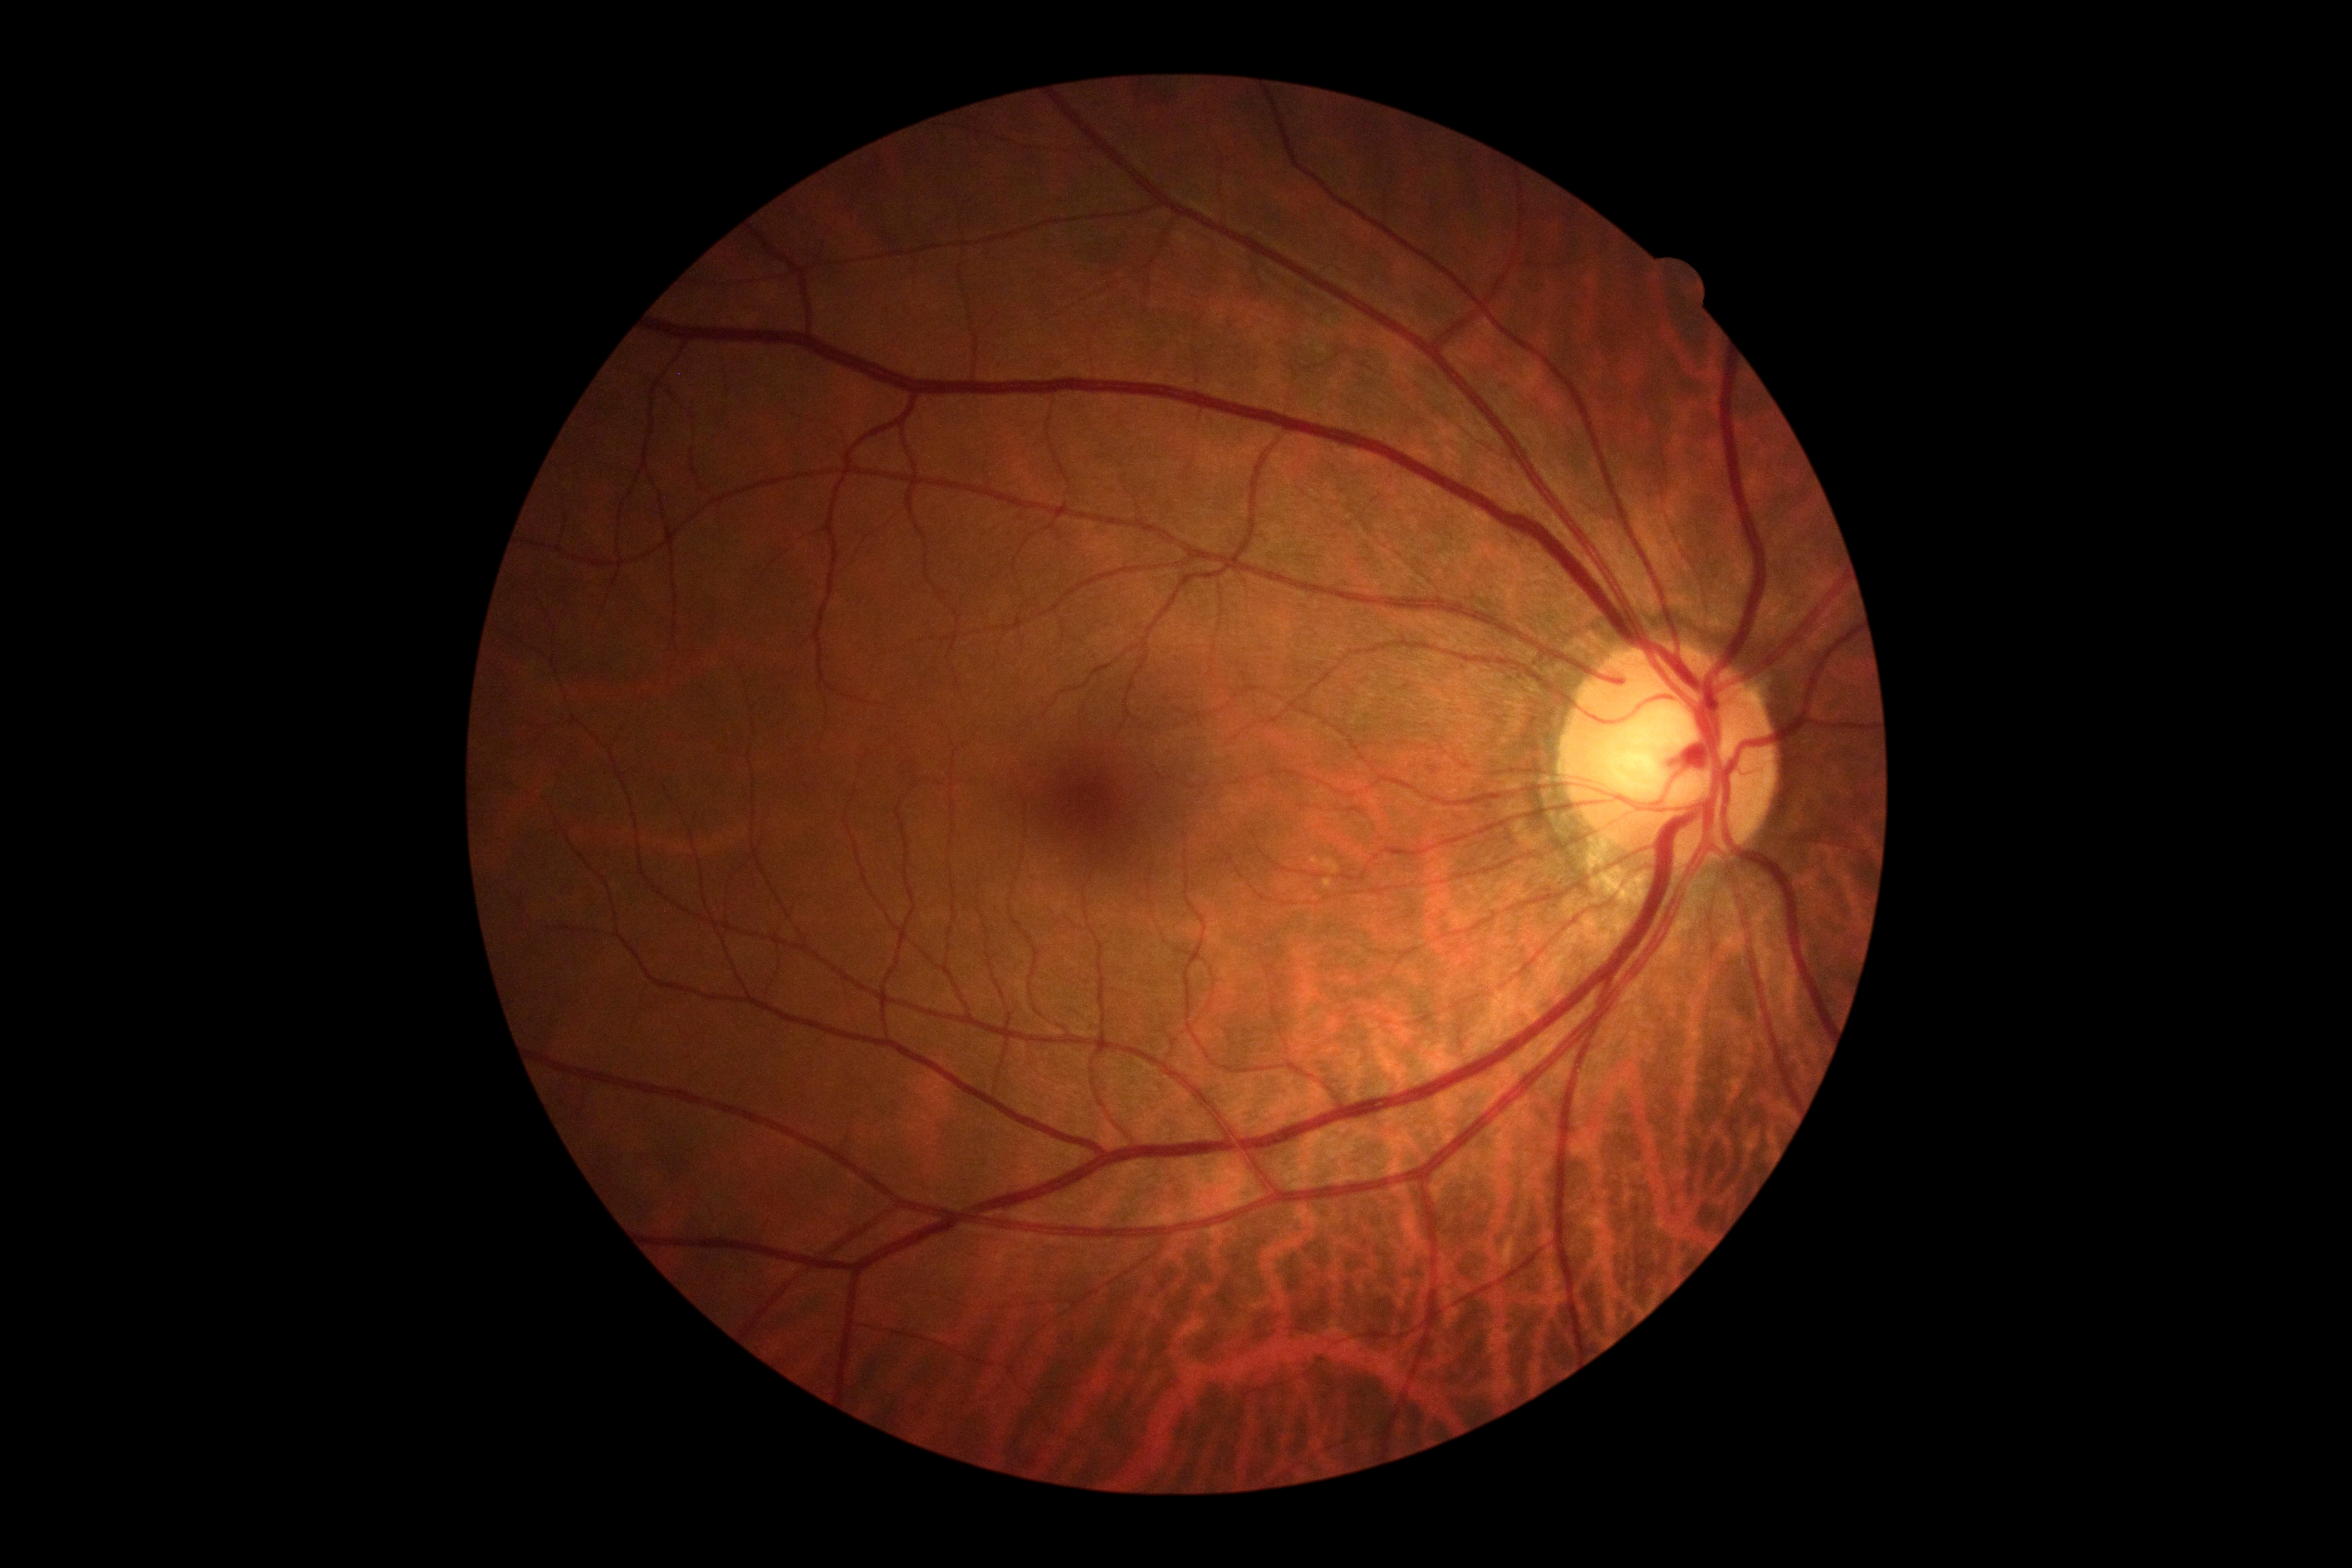 diabetic retinopathy (DR): no apparent diabetic retinopathy (grade 0).